Modified Davis classification — 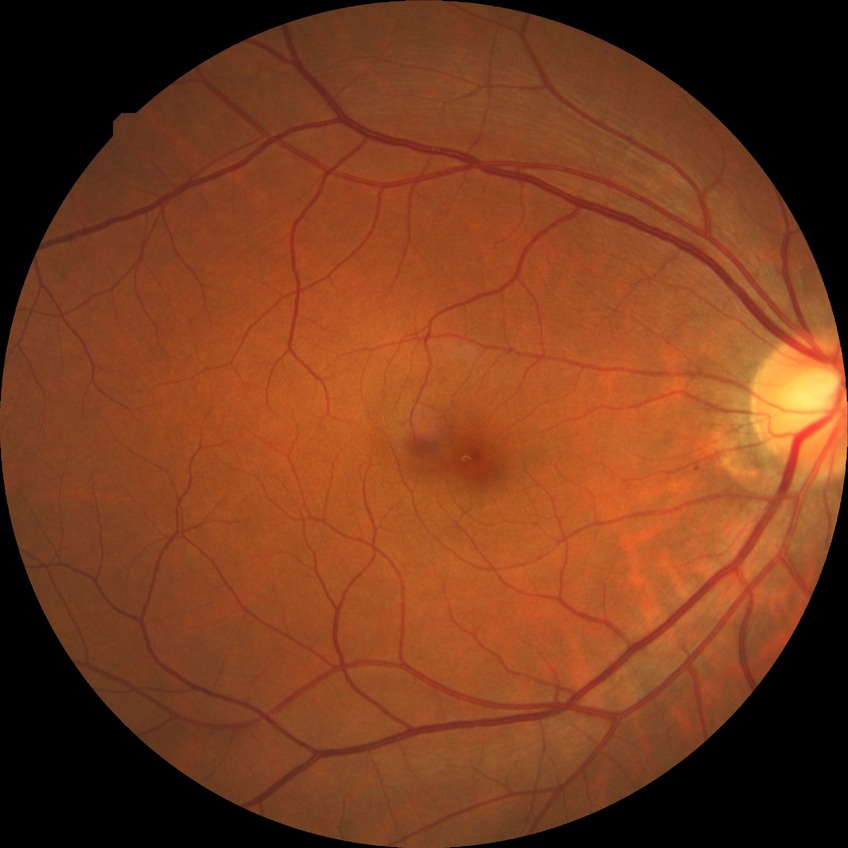
Modified Davis grading: no diabetic retinopathy.